Camera: Phoenix ICON (100° FOV); wide-field fundus photograph of an infant; 1240 x 1240 pixels
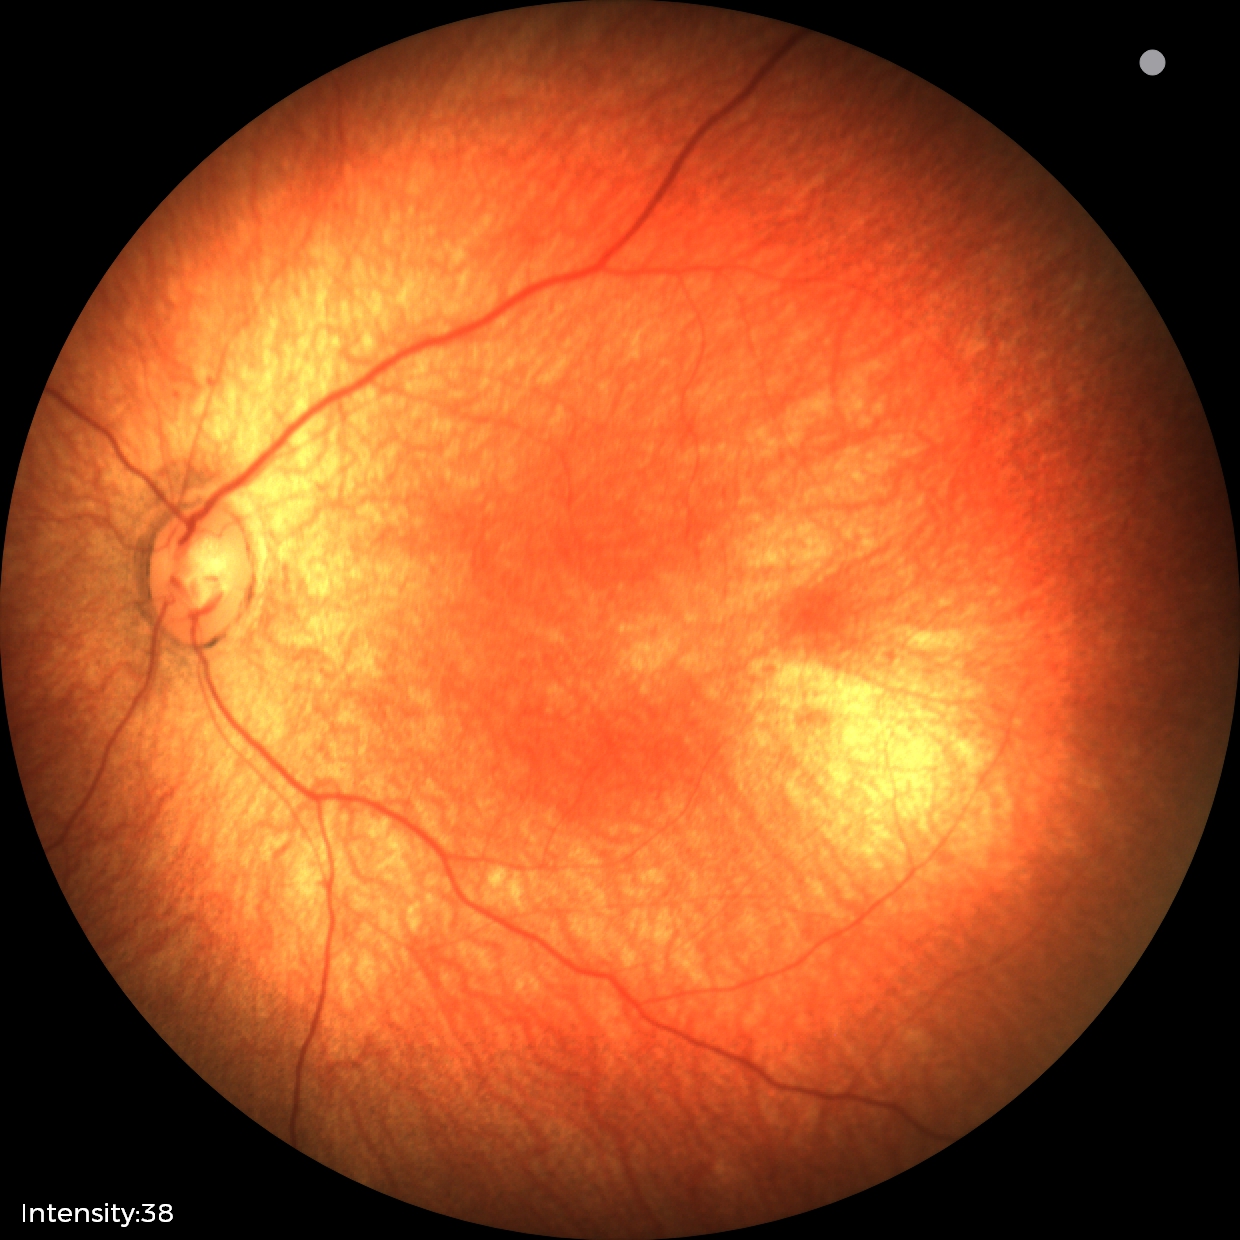 Diagnosis = no abnormalities.